2212x1659.
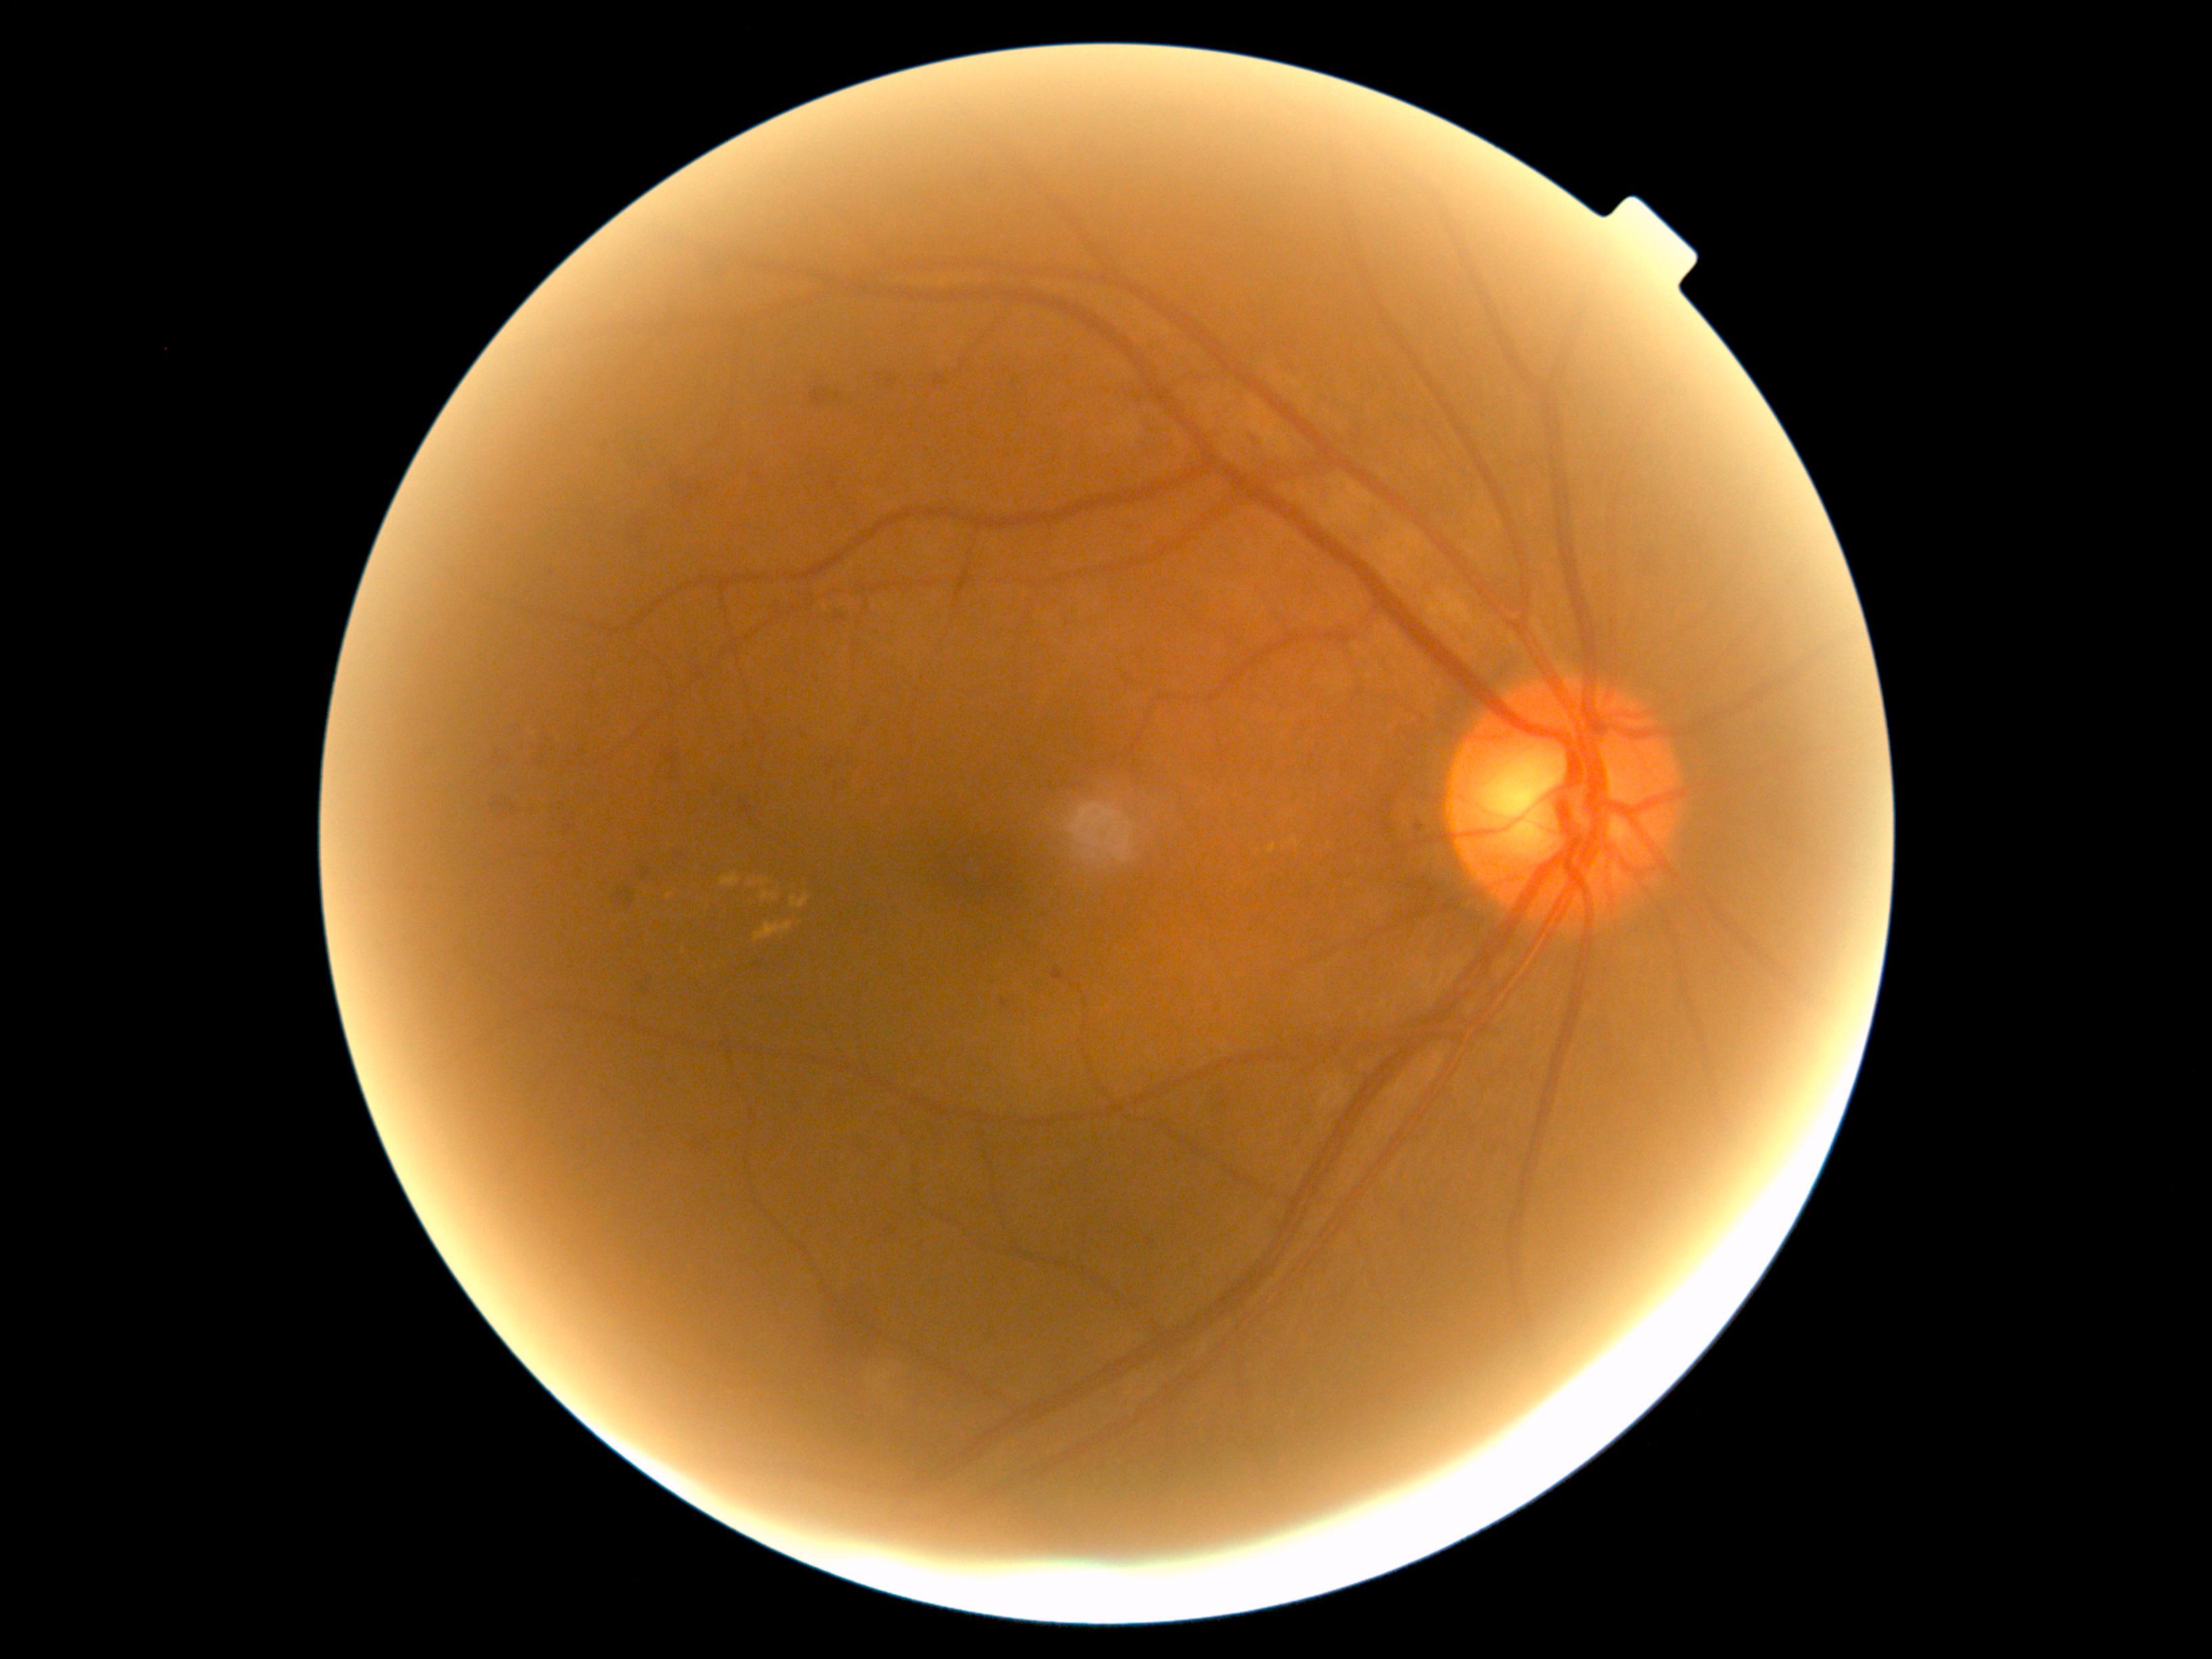
Diabetic retinopathy (DR) is 2
A subset of detected lesions:
hard exudates (EXs) (continued): [754, 922, 794, 943] | [756, 879, 771, 887] | [1290, 837, 1298, 848] | [761, 891, 777, 902] | [720, 876, 739, 888] | [1267, 845, 1276, 855] | [790, 895, 810, 909]
Small EXs near (752, 883) | (669, 897)
microaneurysms (MAs): none identified
hemorrhages (HEs) (continued): [489, 747, 510, 771] | [1638, 544, 1668, 578] | [929, 369, 954, 396] | [829, 480, 840, 490] | [754, 962, 762, 970] | [705, 783, 722, 803] | [668, 848, 692, 871] | [810, 1286, 887, 1359] | [636, 861, 651, 883] | [738, 798, 764, 829] | [527, 745, 555, 769] | [623, 518, 653, 550] | [810, 670, 822, 687] | [1207, 1082, 1241, 1126] | [818, 753, 841, 776] | [627, 960, 655, 1002] | [742, 735, 752, 749]
Small HEs near (754, 476) | (553, 575)
soft exudates (SEs): none identified